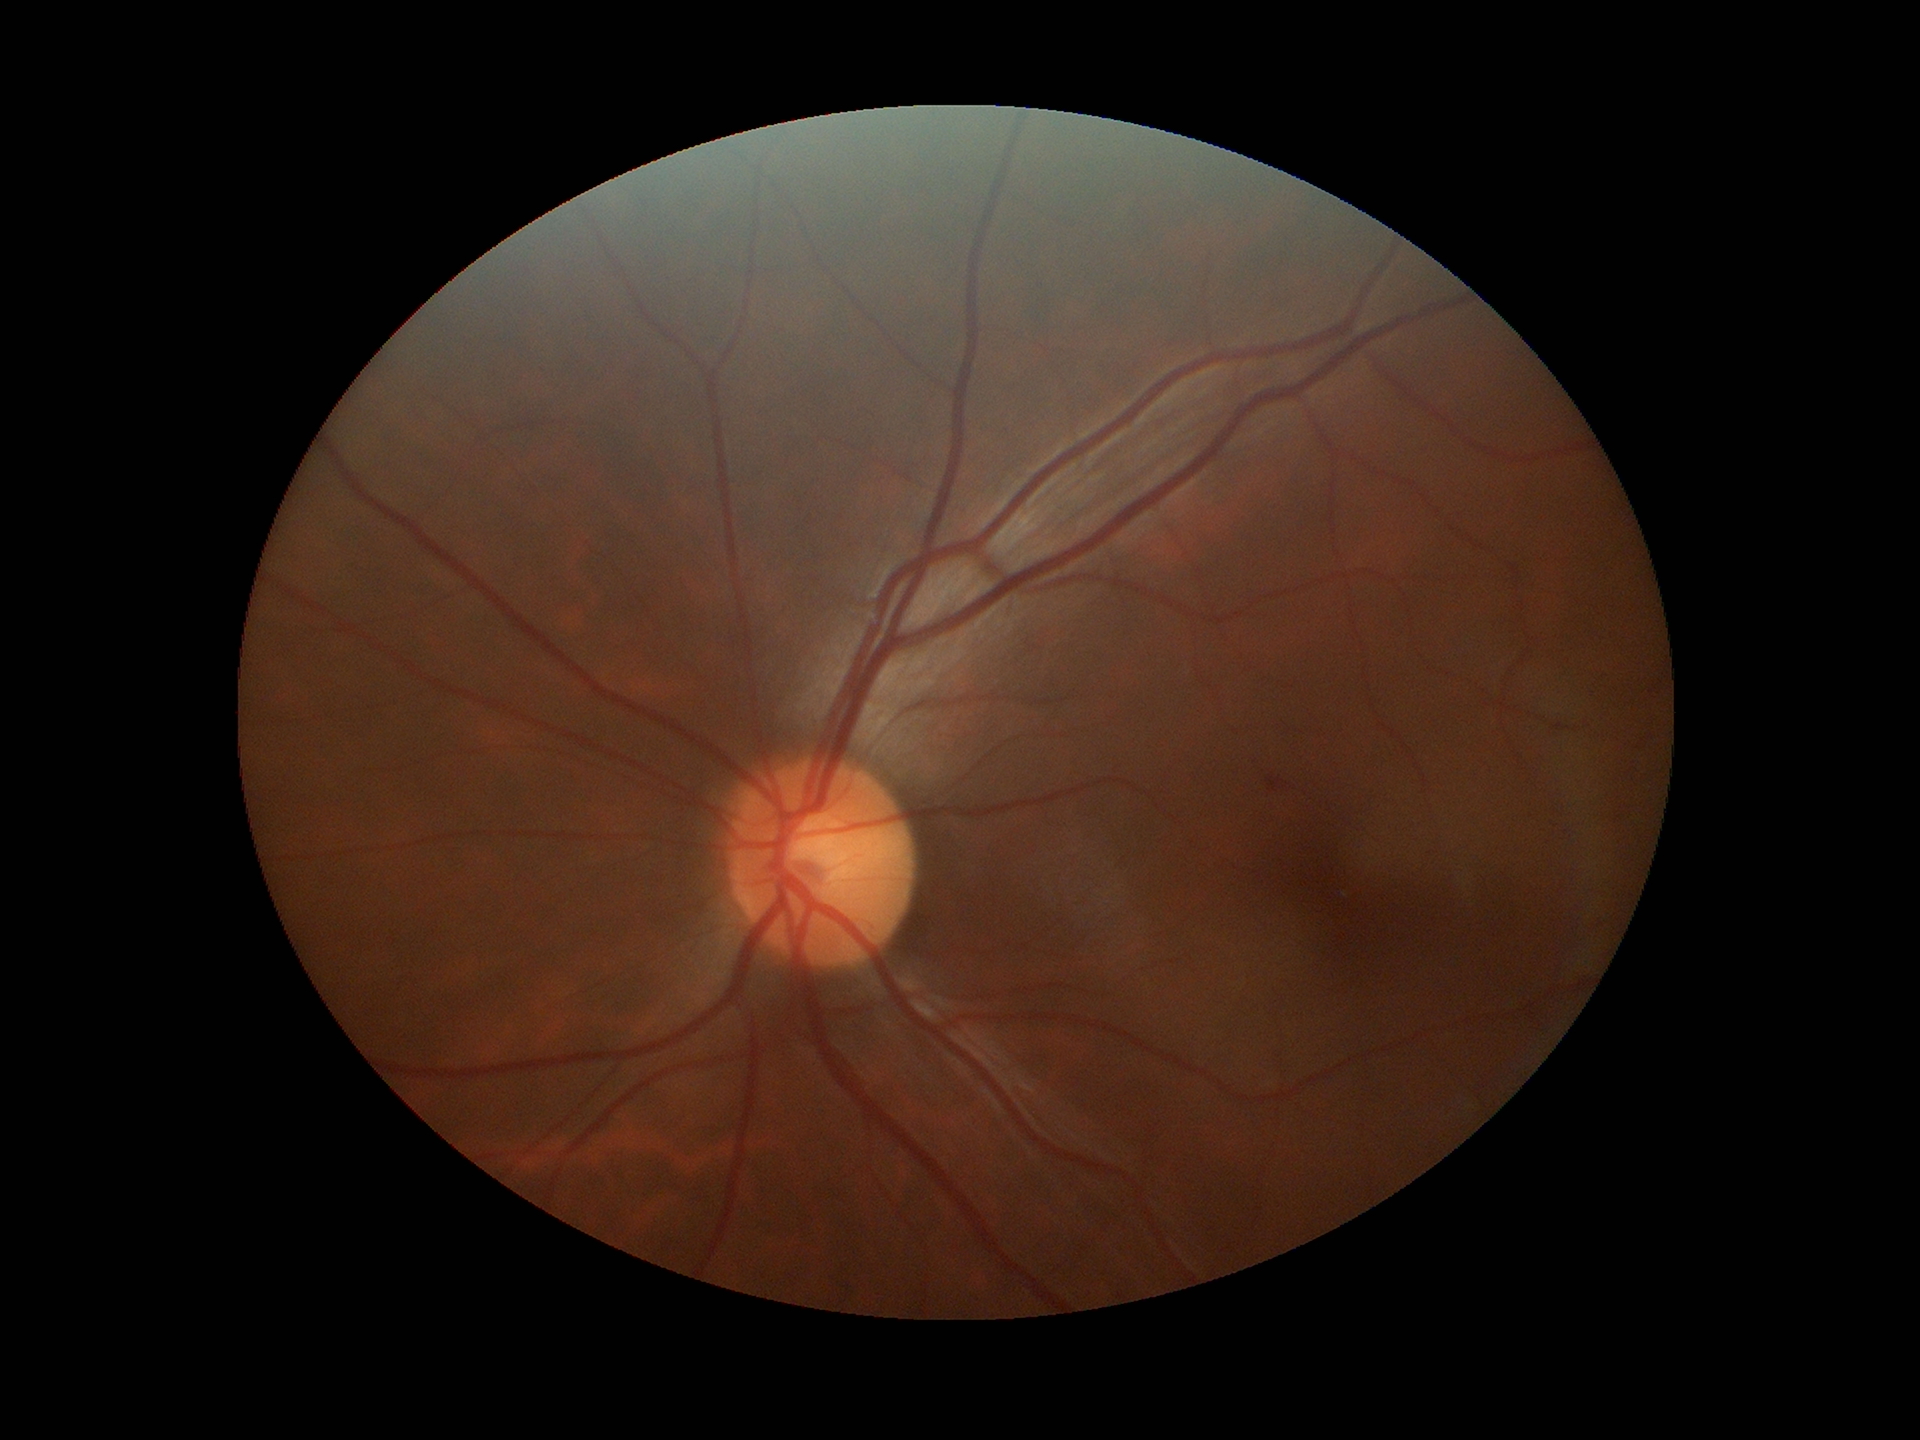
Glaucoma decision: not suspect.
Area cup-to-disc ratio (ACDR) of 0.24.
Vertical CDR (VCDR) is 0.48.